Camera: NIDEK AFC-230. Color fundus photograph. 848 by 848 pixels:
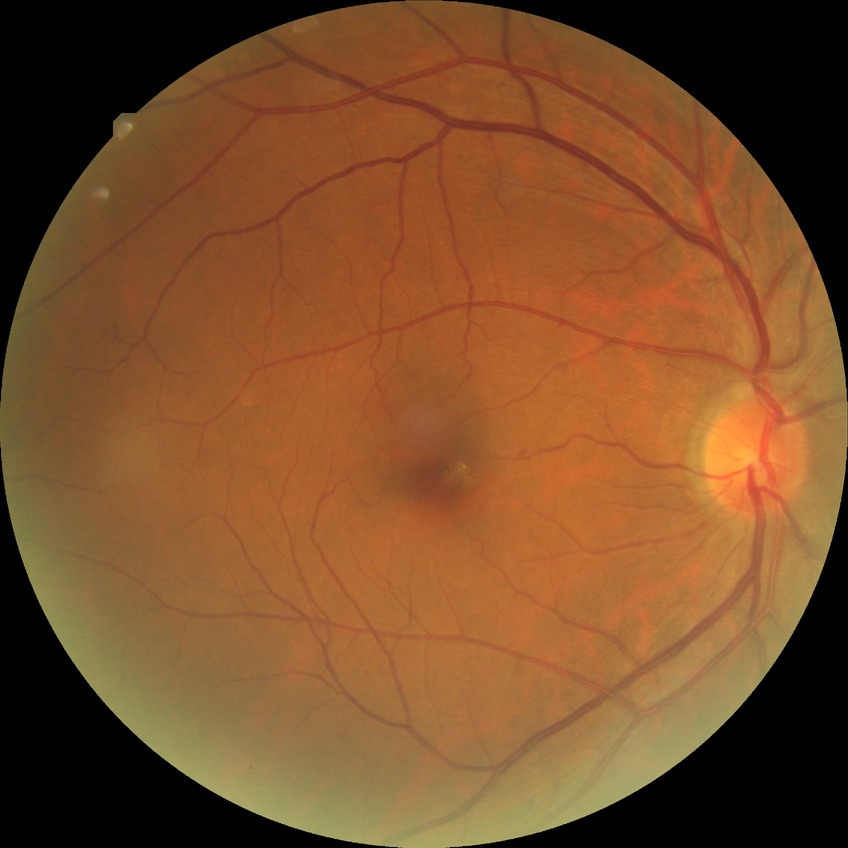
Annotations:
• diabetic retinopathy (DR) — no diabetic retinopathy (NDR)